UWF retinal mosaic:
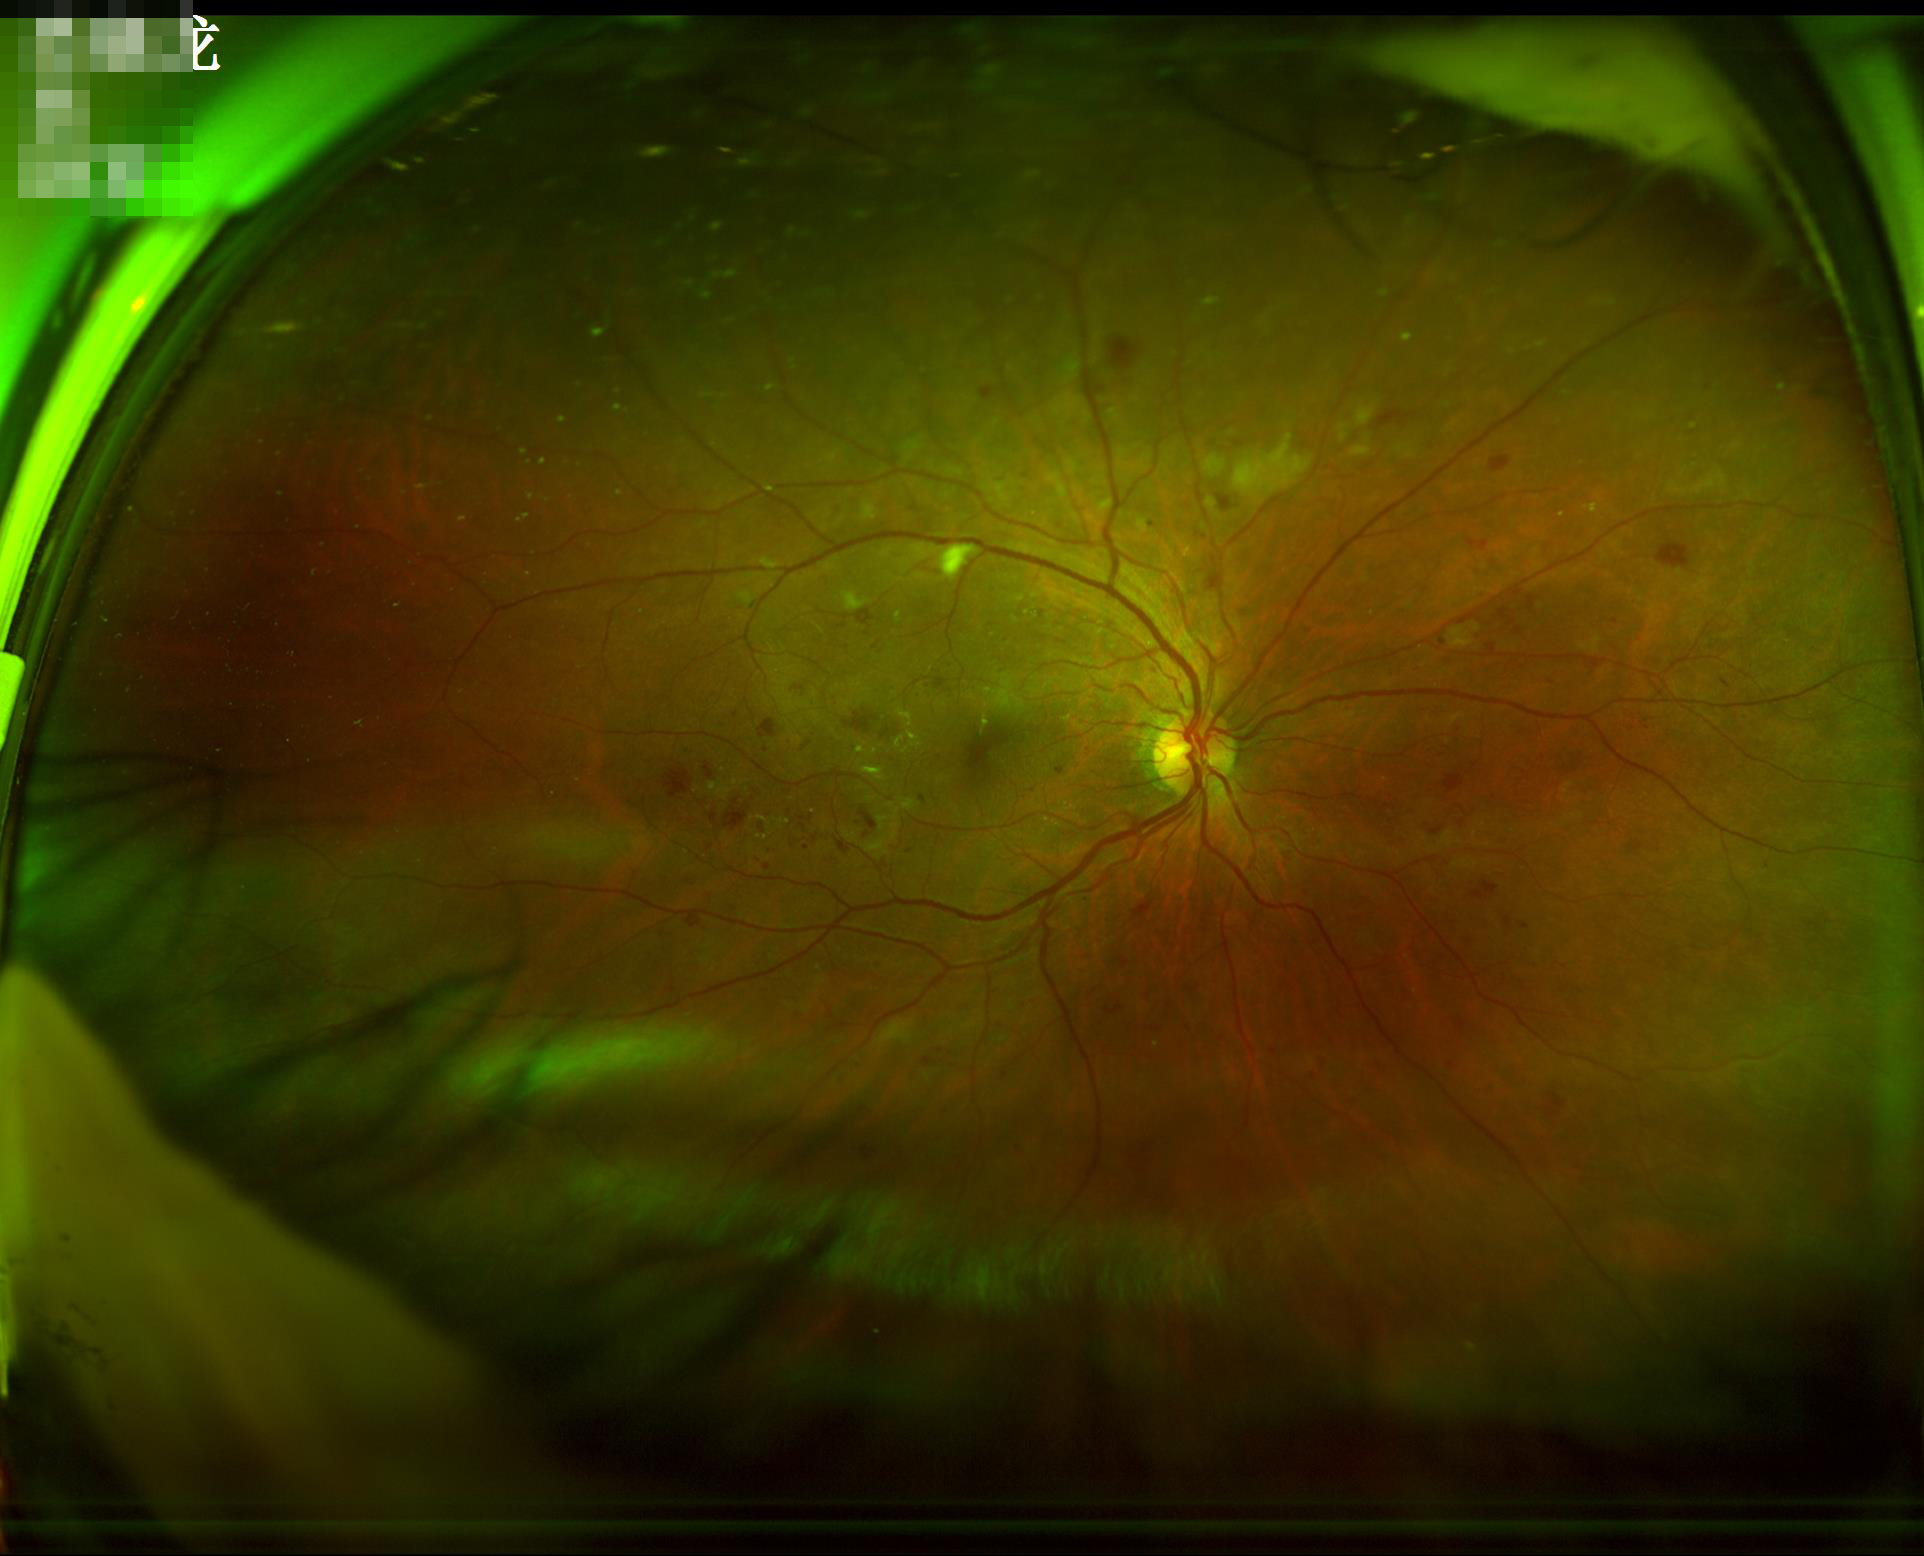 No over- or under-exposure.
Overall image quality is good.
Image is sharp throughout the field.